640 x 480 pixels. Acquired on the Clarity RetCam 3. Wide-field contact fundus photograph of an infant
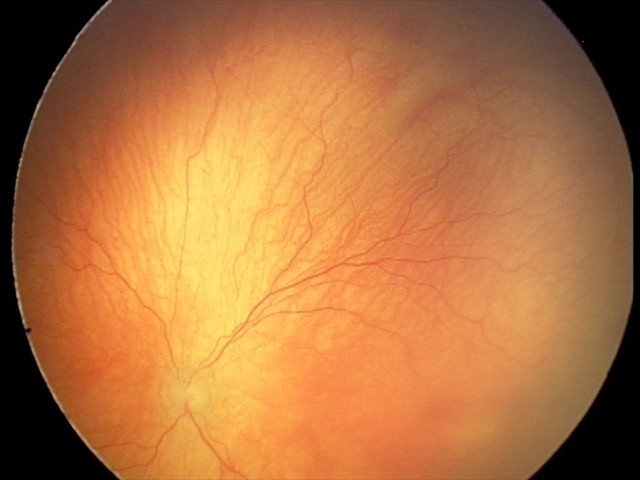 Q: What was the screening finding?
A: aggressive retinopathy of prematurity (A-ROP)